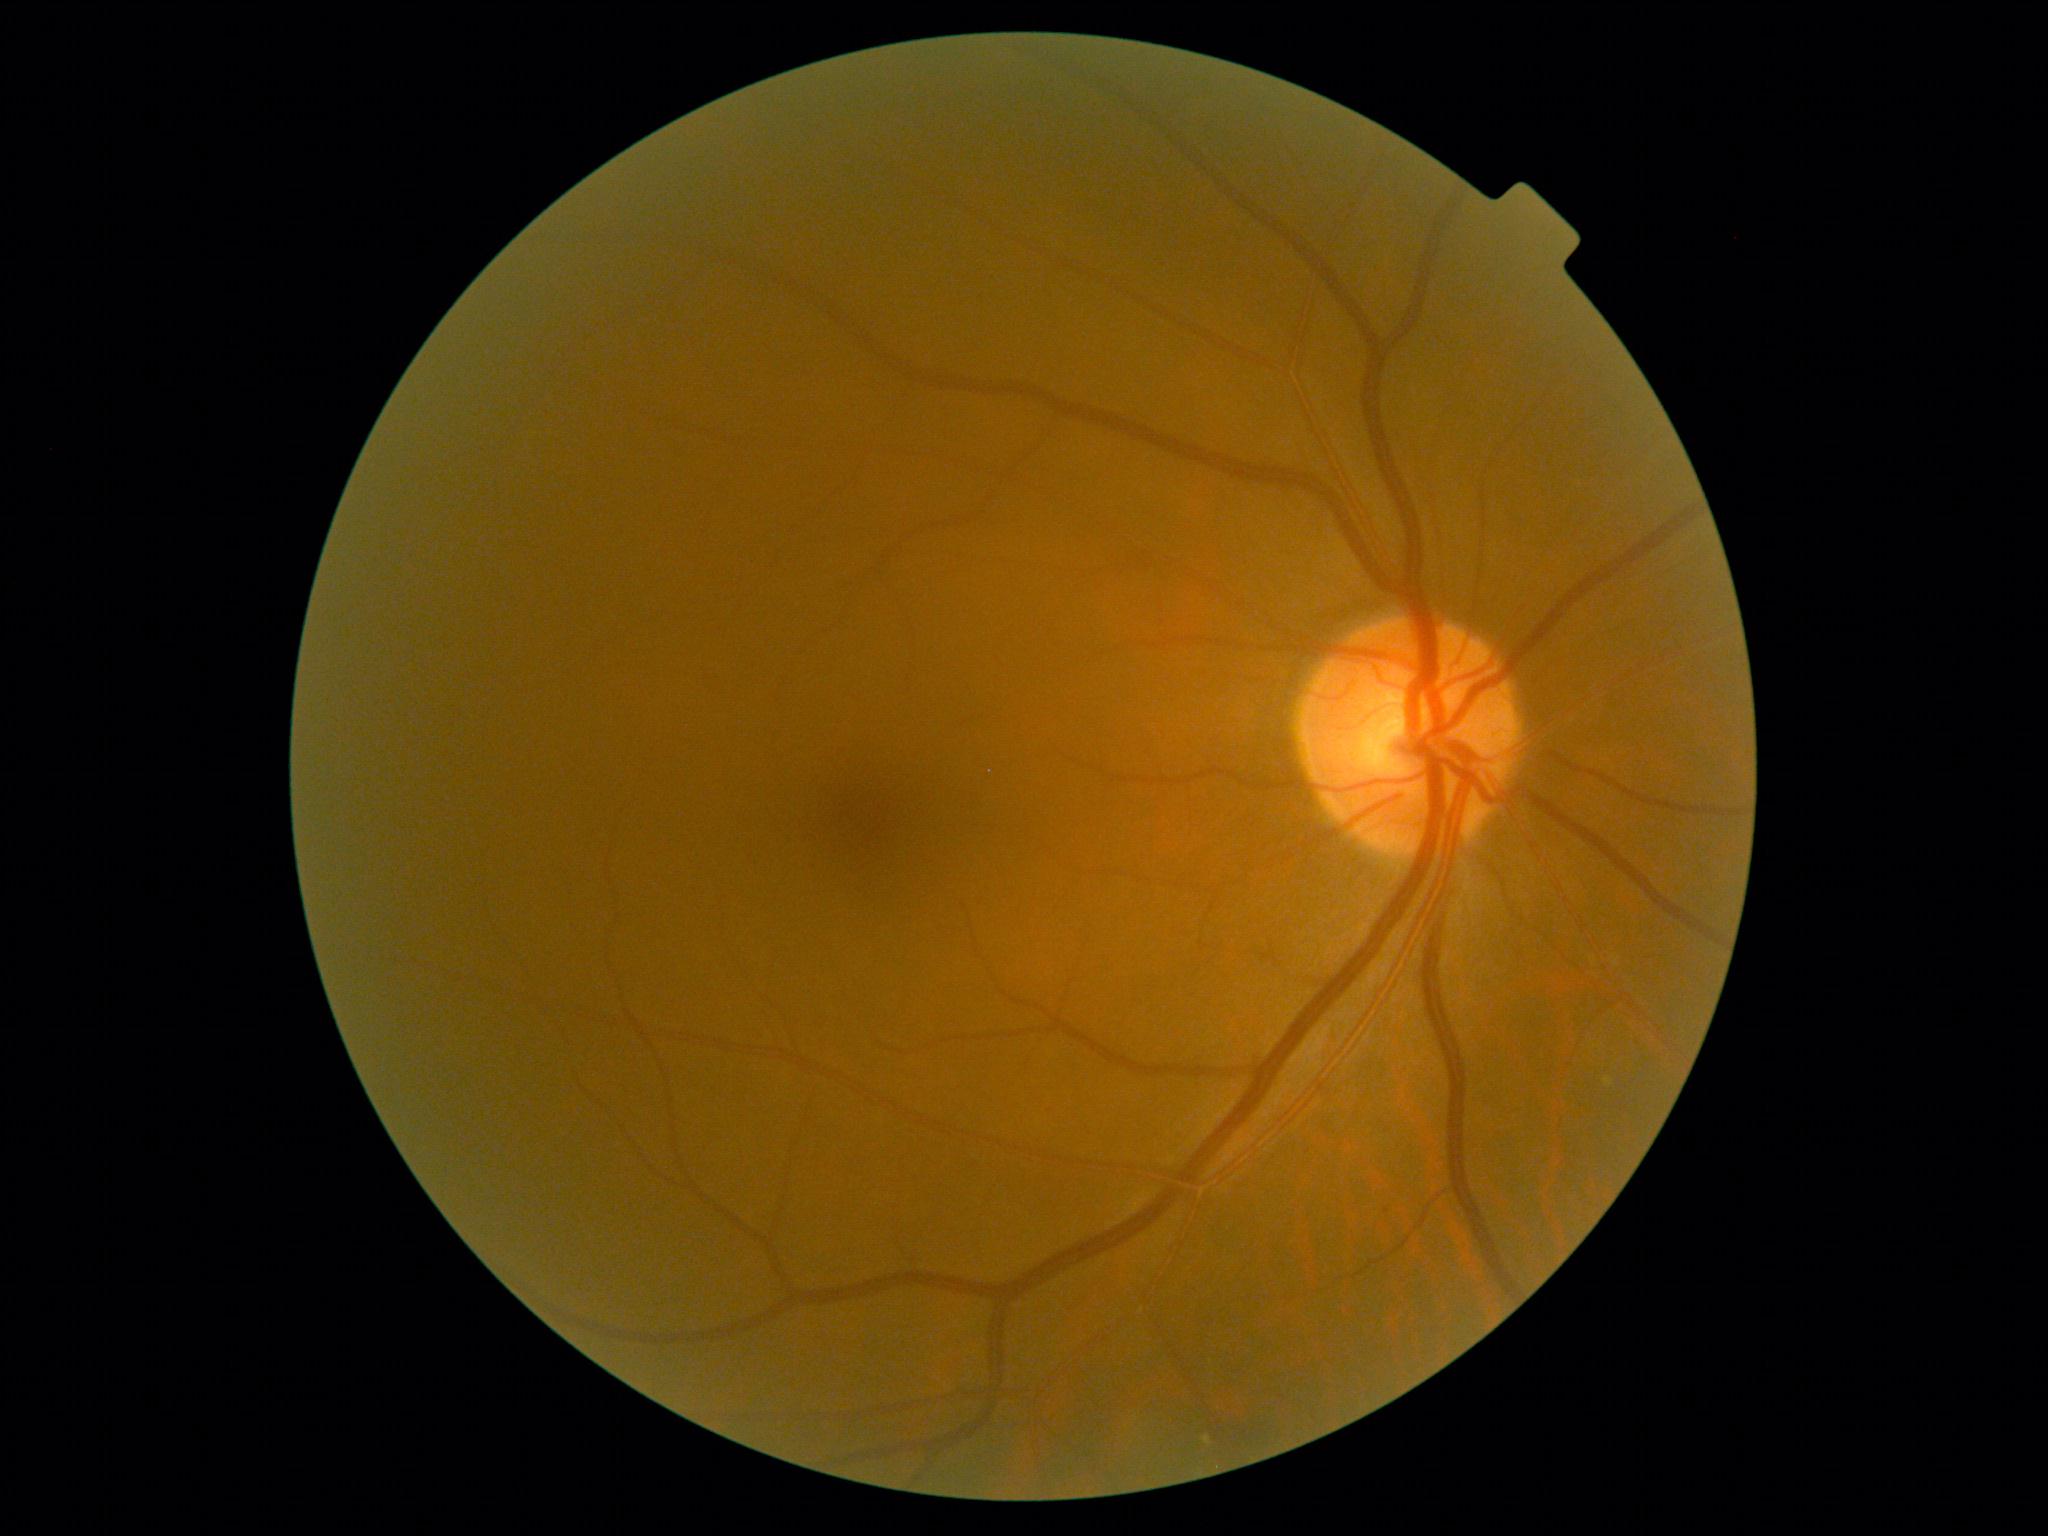

No diabetic retinal disease findings. Diabetic retinopathy grade is 0/4.